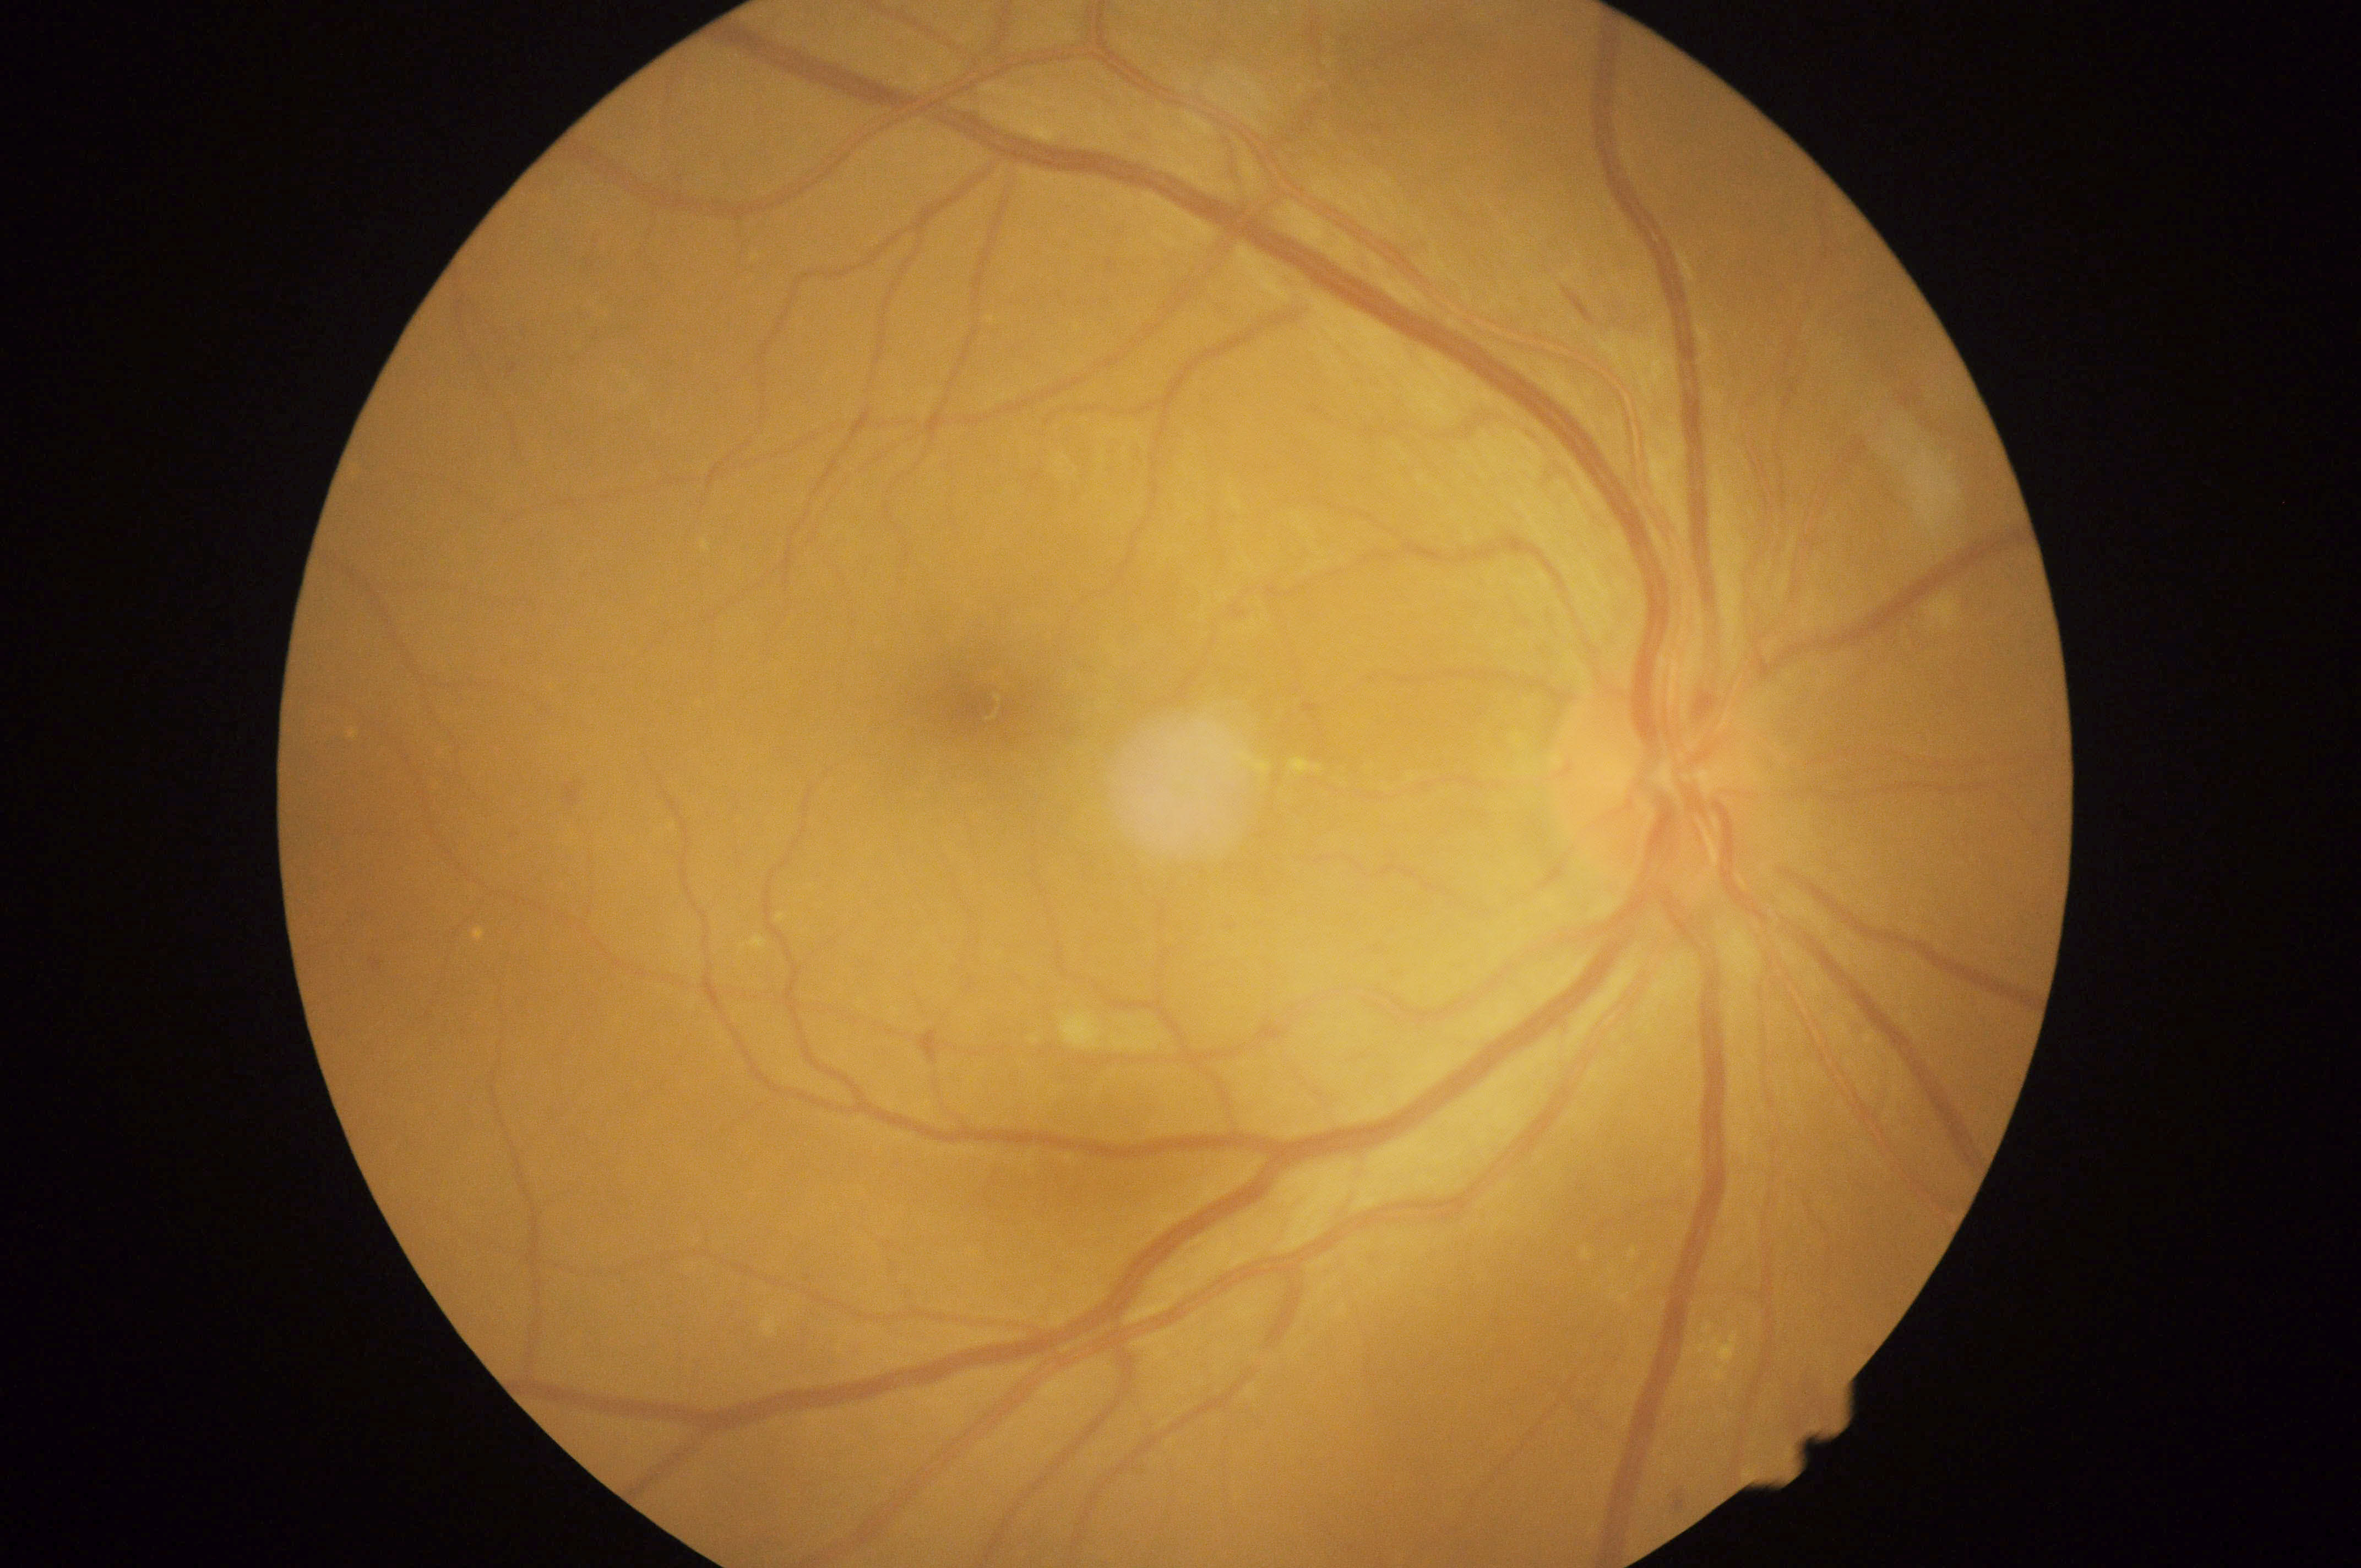 diabetic retinopathy = moderate non-proliferative diabetic retinopathy (grade 2).